Color fundus photograph. Captured on a Remidio Fundus on Phone.
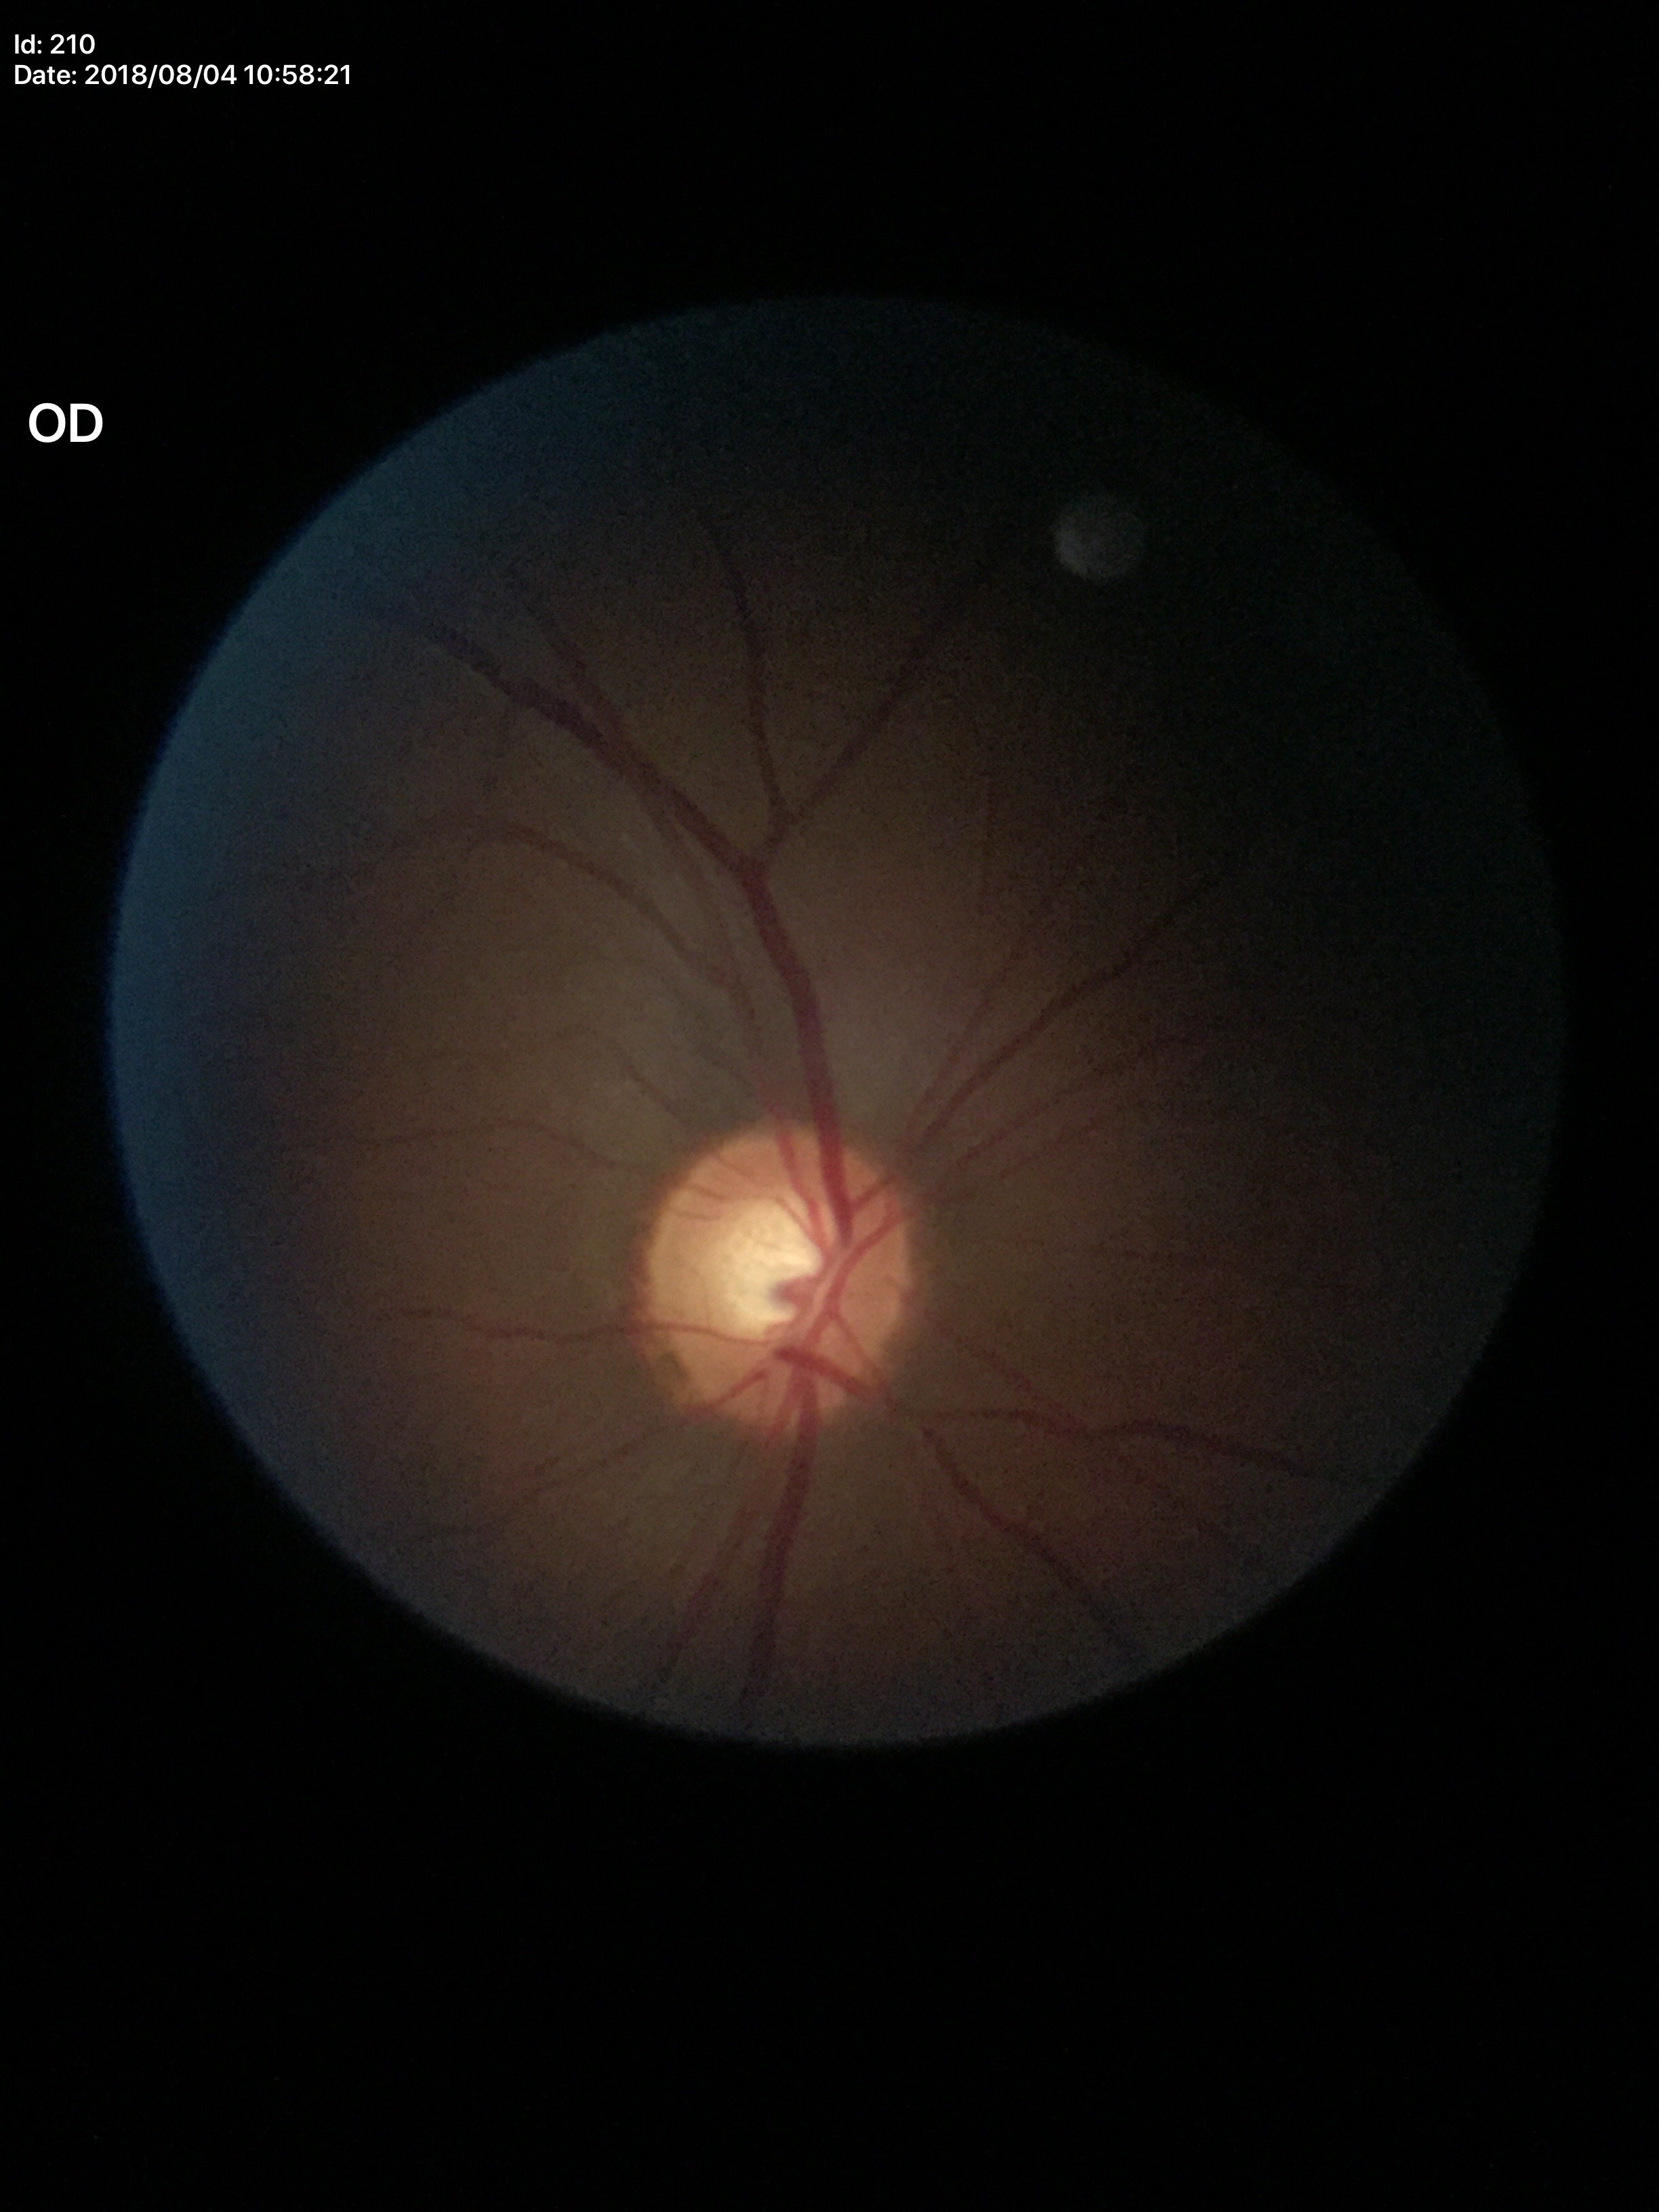 Glaucoma decision: suspicious.
Vertical CDR is 0.60.